Color fundus photograph: 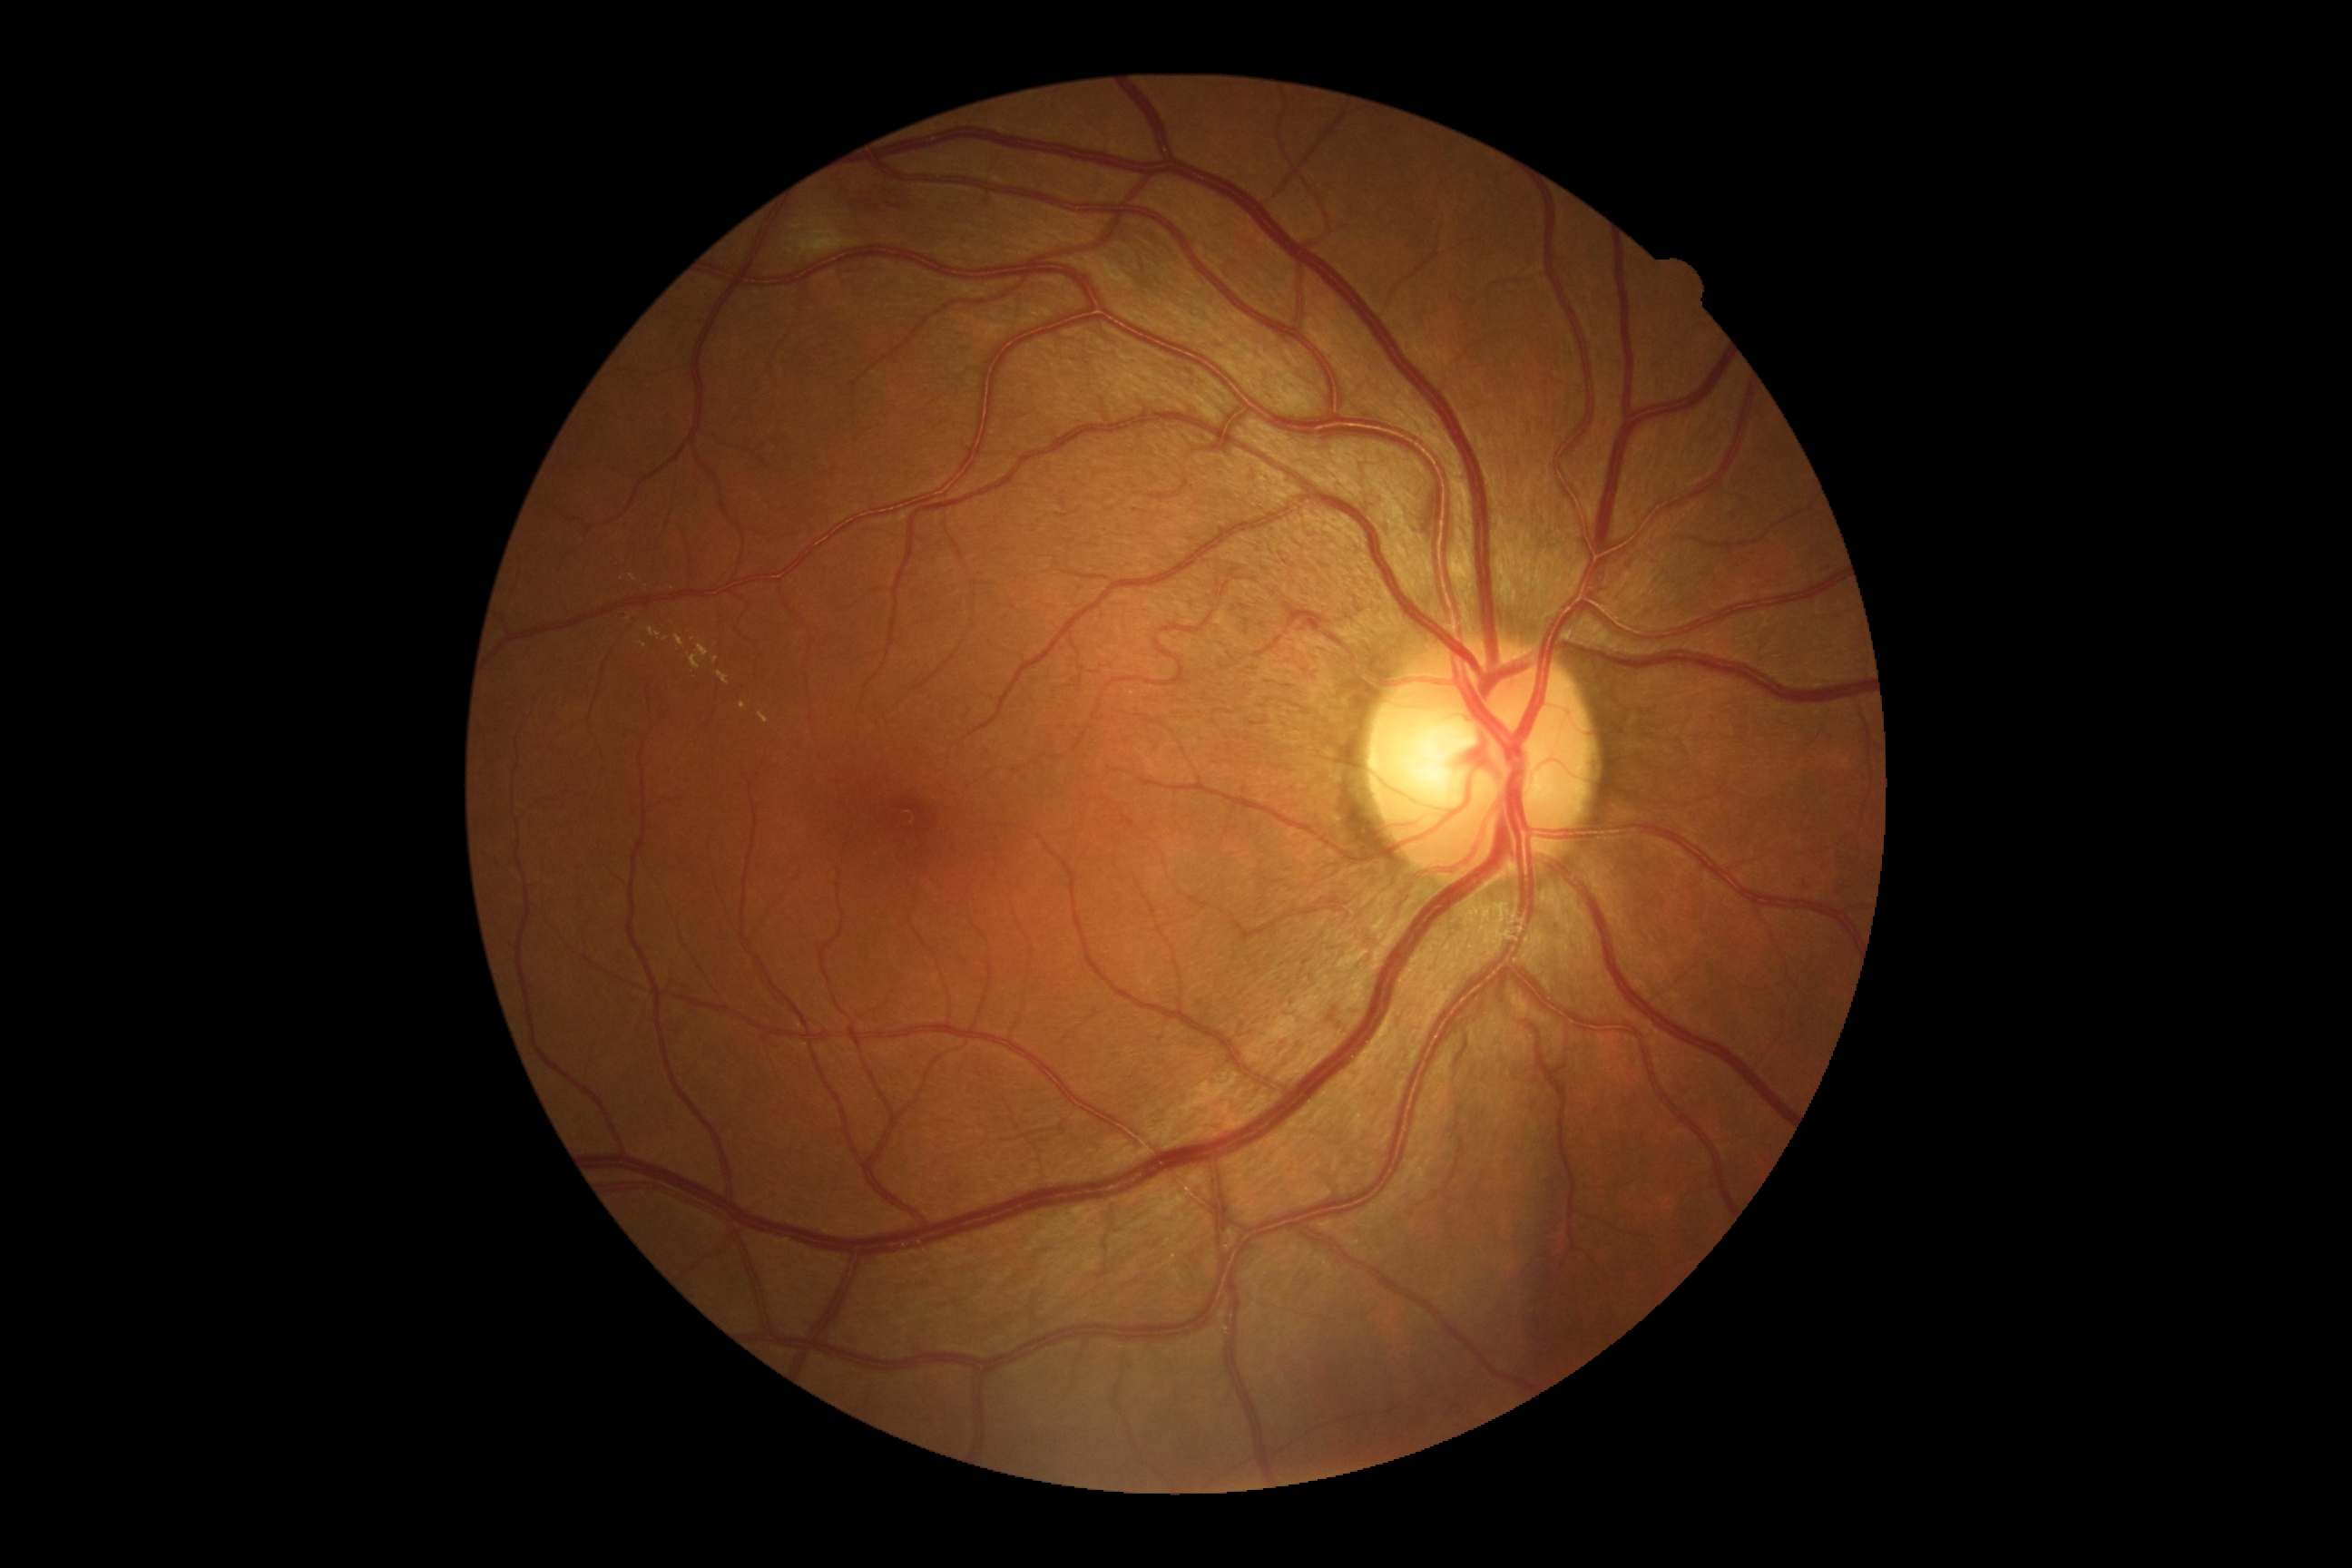

DR grade is moderate non-proliferative diabetic retinopathy (2).